Captured on a Topcon TRC retinal camera, disc-centered fundus crop:
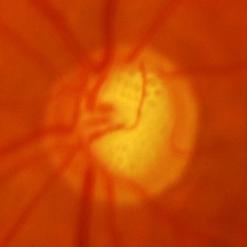 Optic disc appearance consistent with evidence of glaucoma.